Image size 1659x2212 — 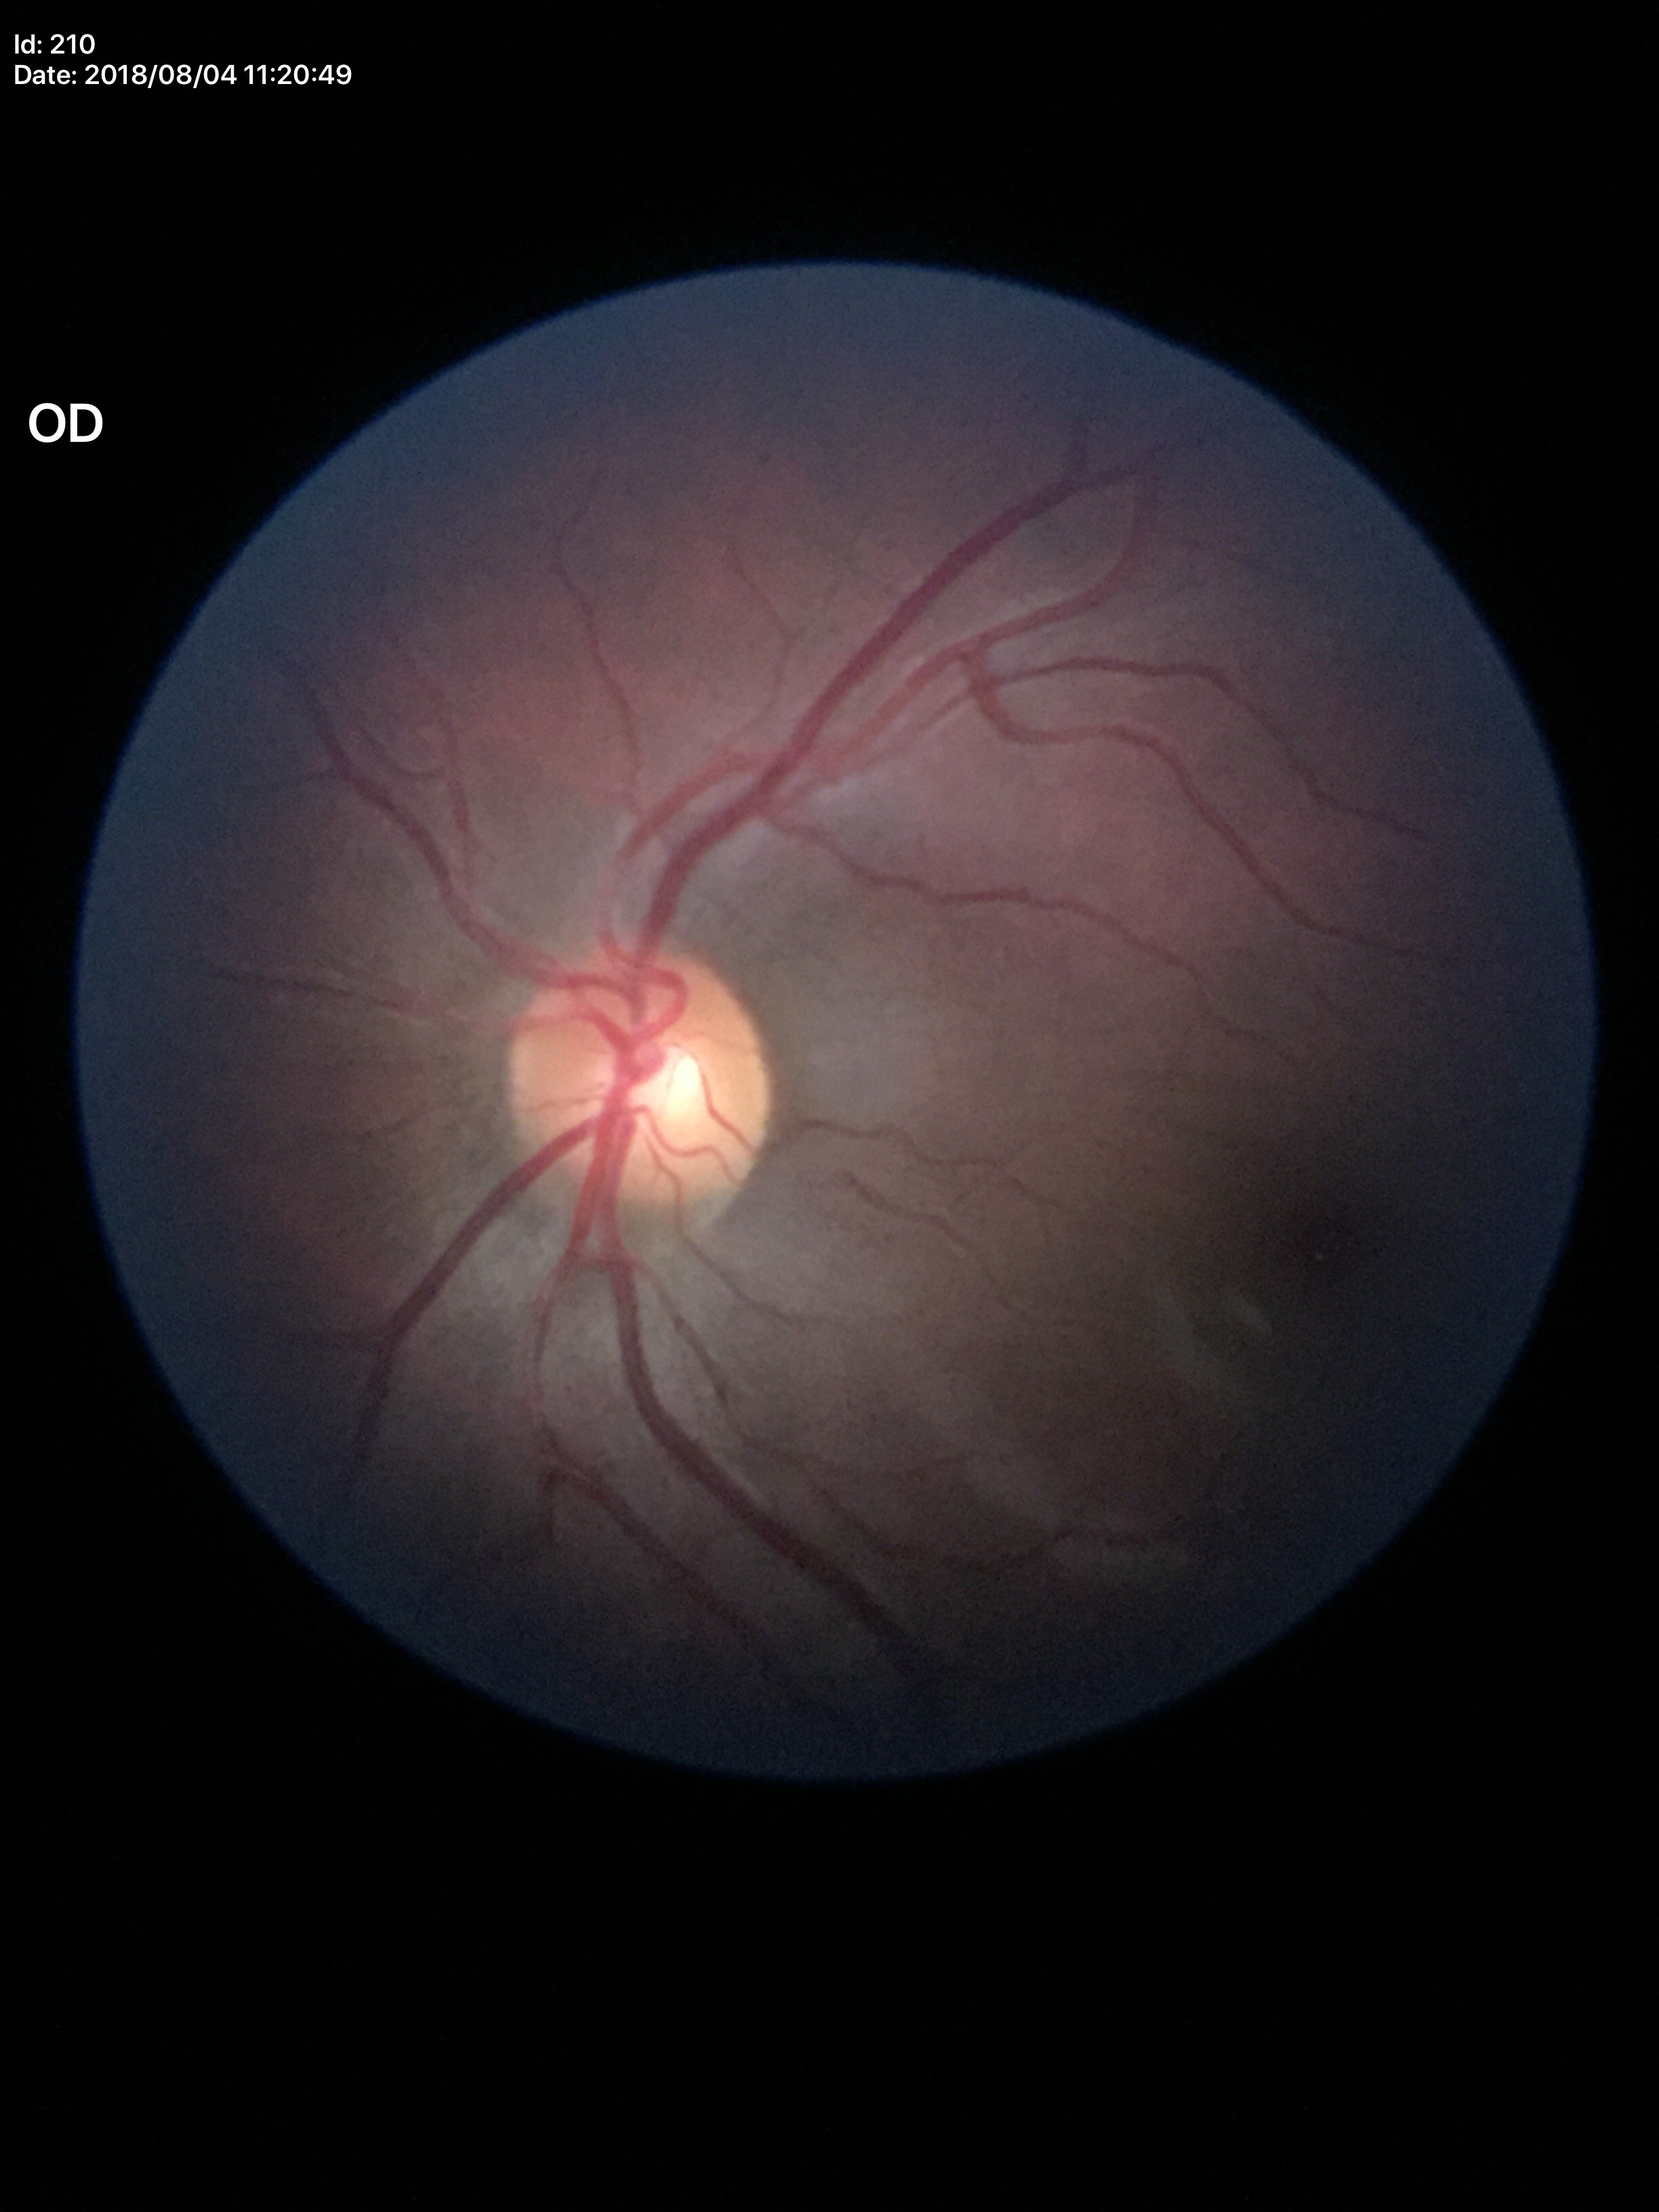 Vertical cup-to-disc ratio is 0.49. Horizontal CDR of 0.49. Glaucoma evaluation: negative.